Wide-field fundus photograph of an infant.
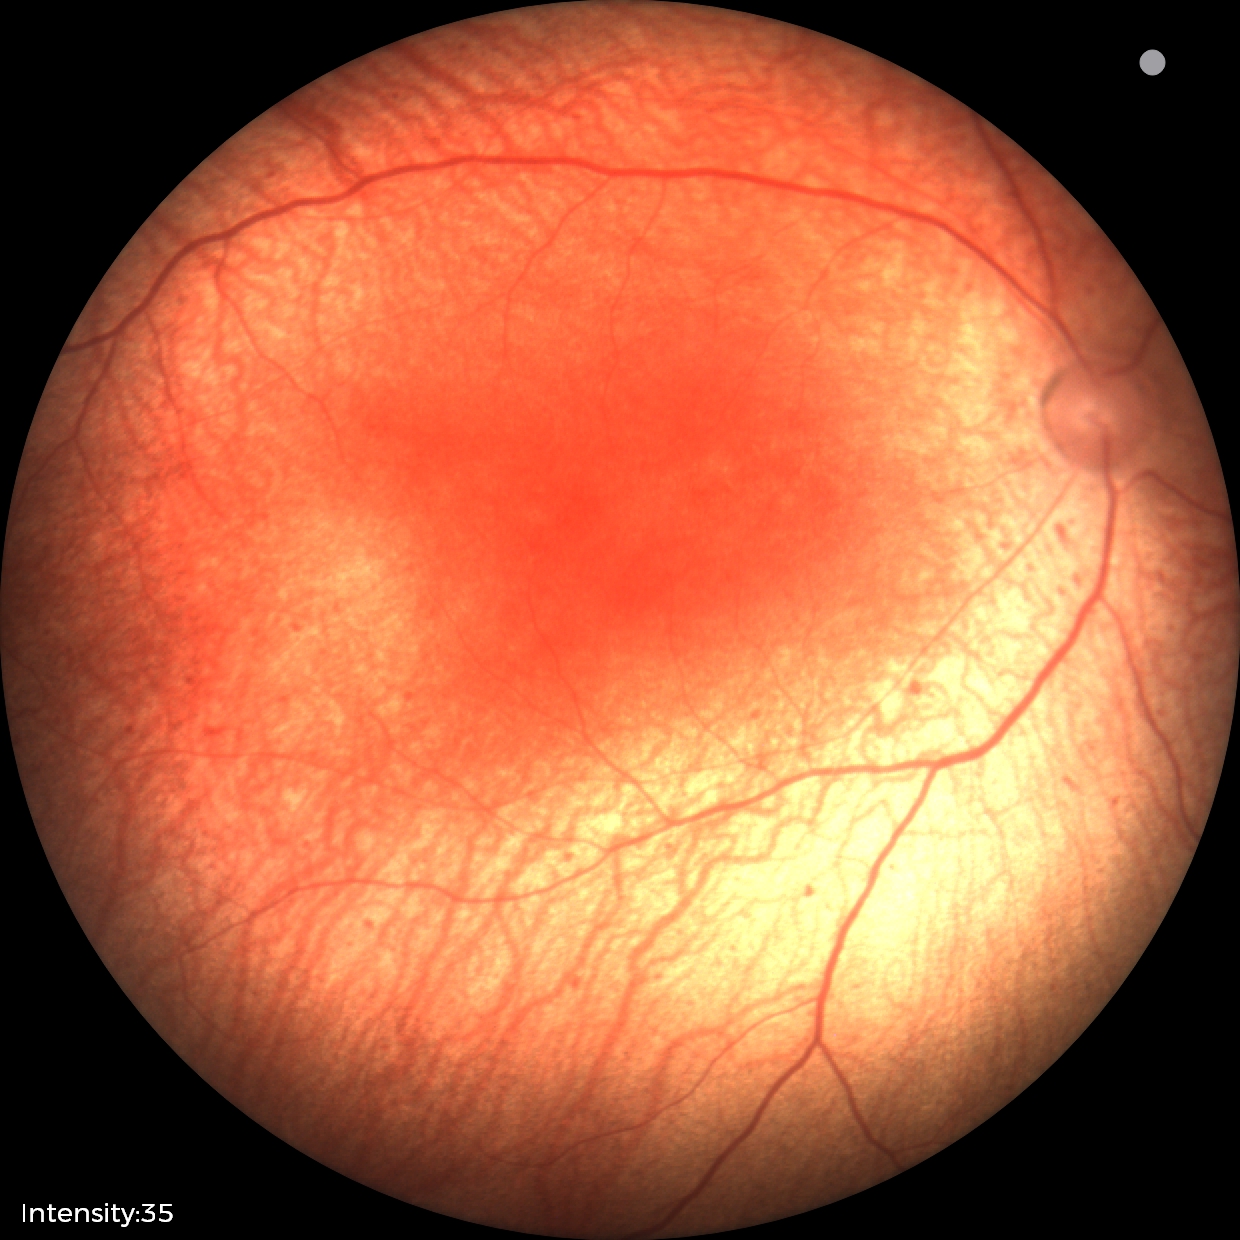
Series diagnosed as status post retinopathy of prematurity.